848x848; retinal fundus photograph: 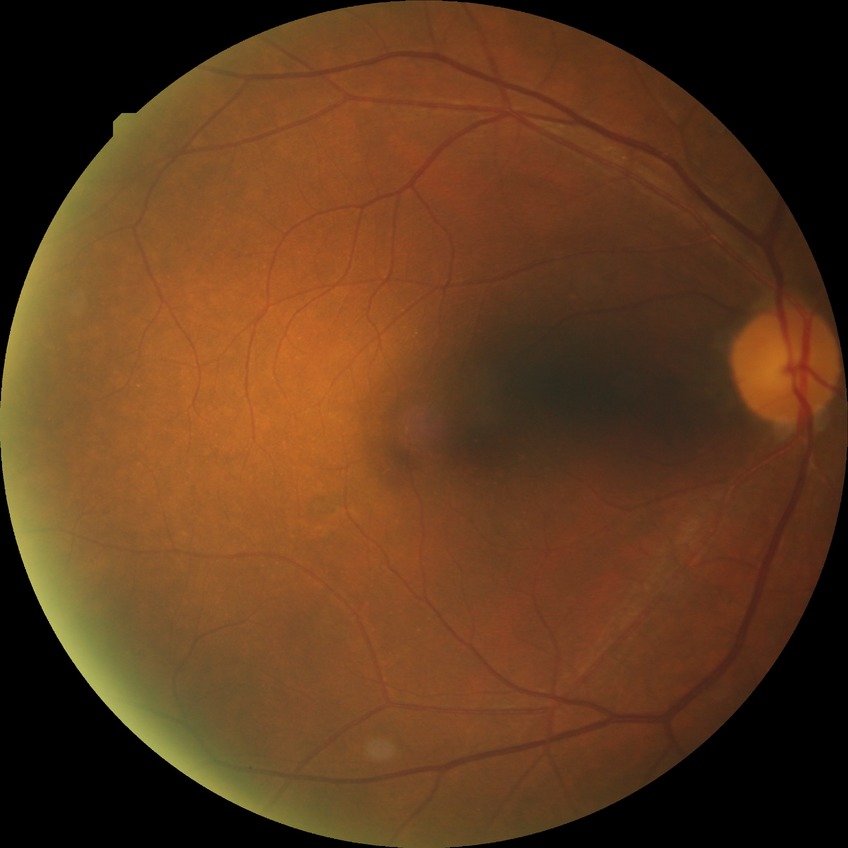

Annotations:
- diabetic retinopathy (DR) — no diabetic retinopathy (NDR)